Acquired on the Natus RetCam Envision. Wide-field fundus photograph of an infant. 1440x1080: 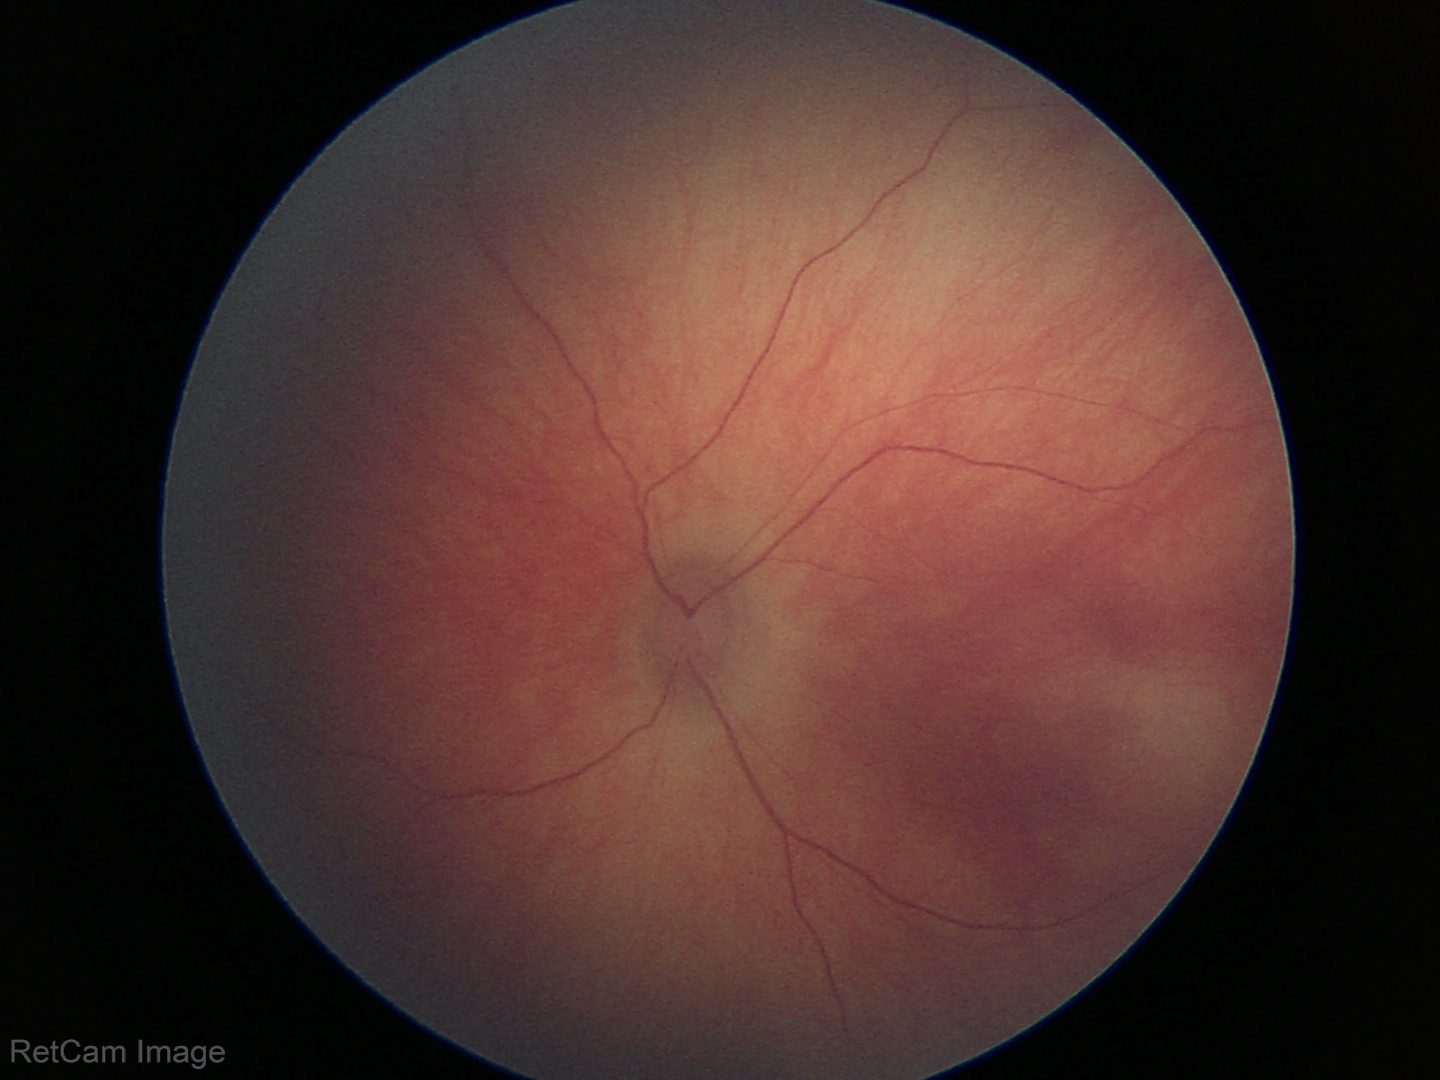

Q: What is the screening diagnosis?
A: normal fundus examination